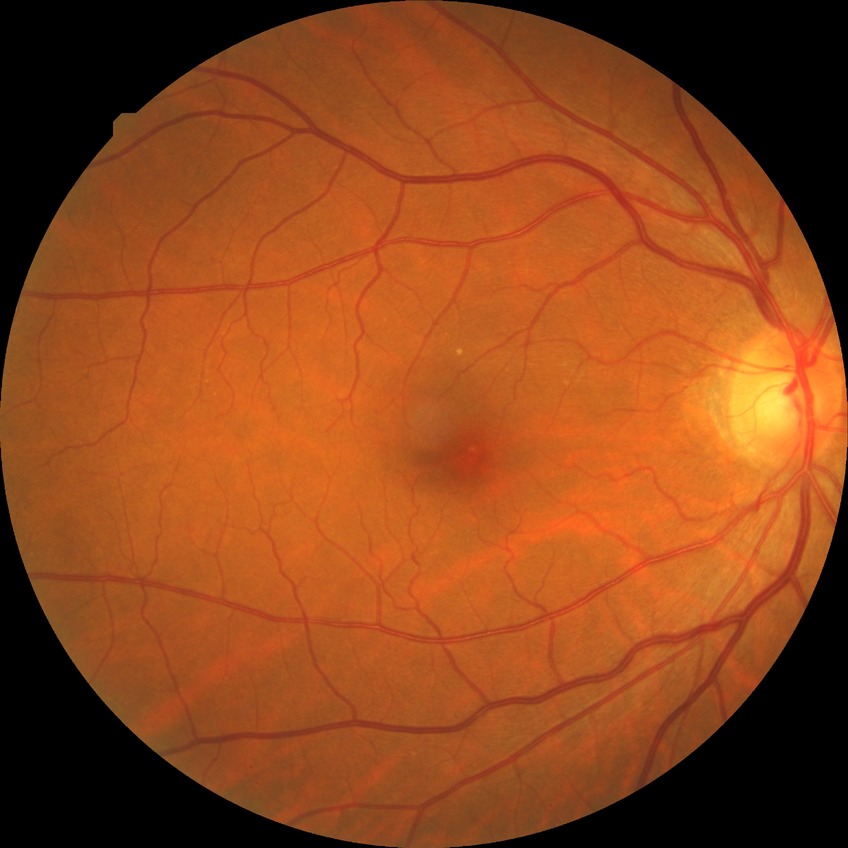
retinopathy stage = no diabetic retinopathy